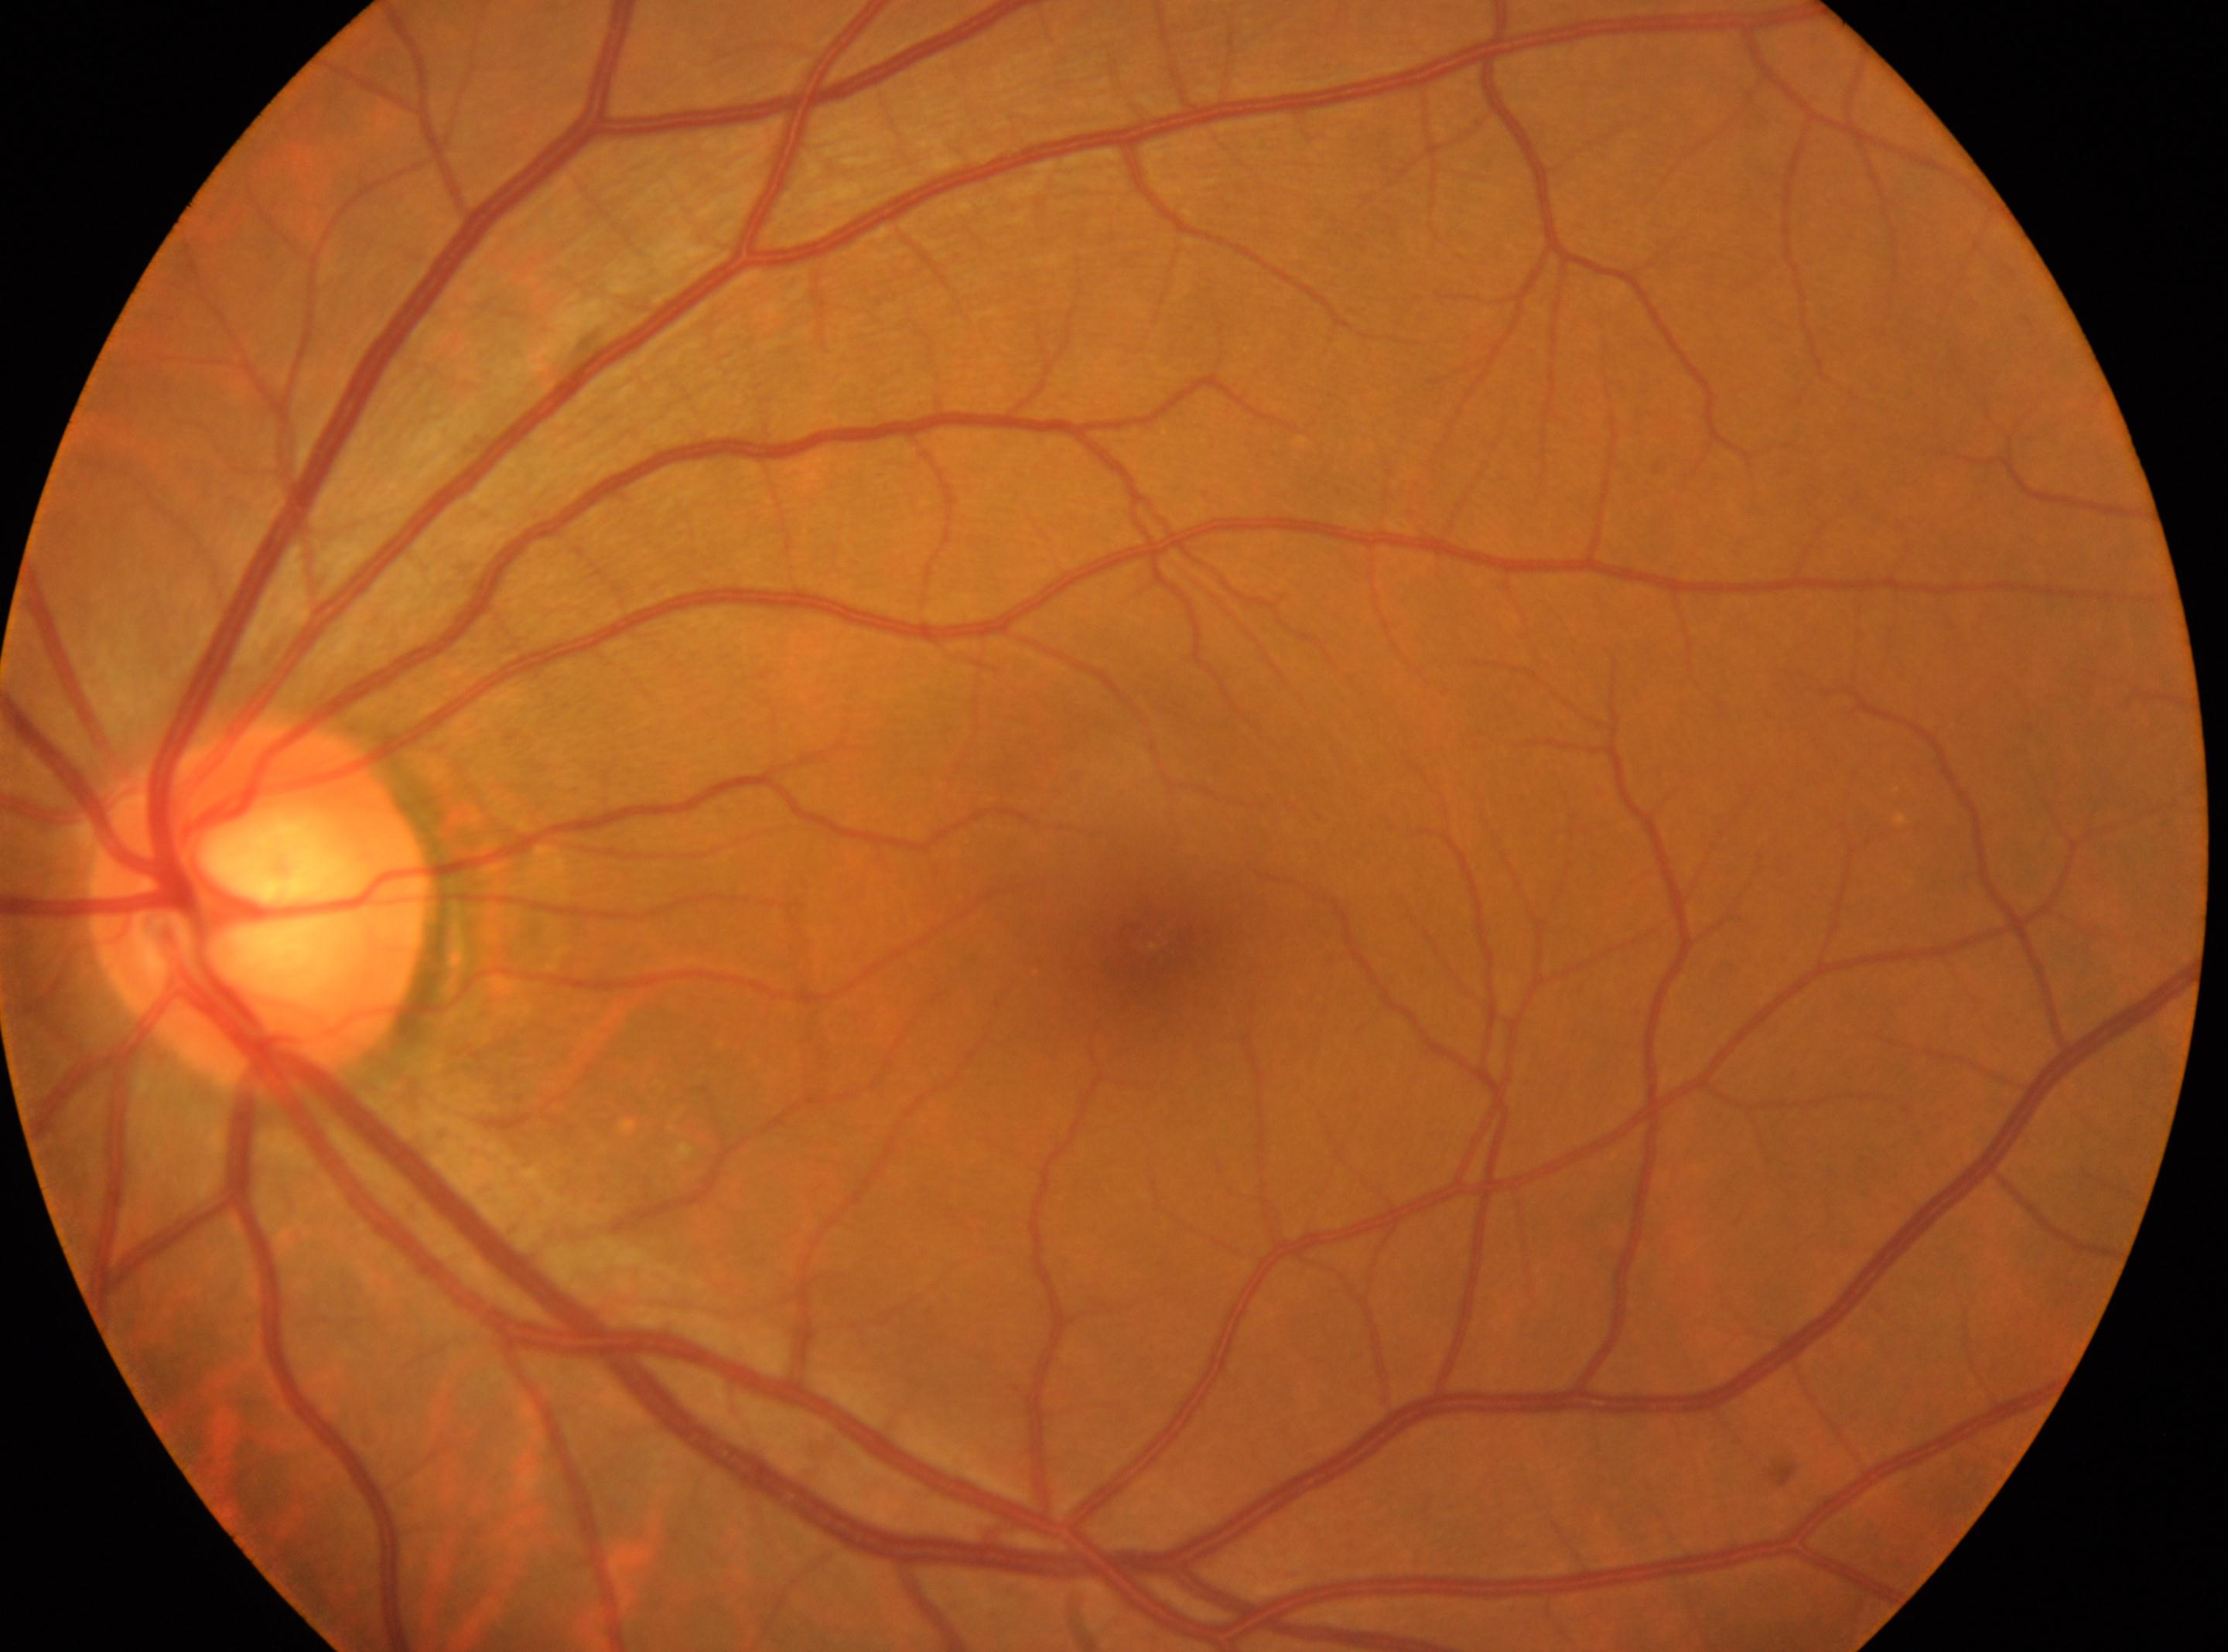
Foveal center located at 1153, 936. DR: grade 0 (no apparent retinopathy). This is the oculus sinister. Optic disc located at 260, 905.